Corneal thickness: 450 µm · camera: Topcon TRC-NW400 · intraocular pressure (IOP) 12 mmHg · CFP.
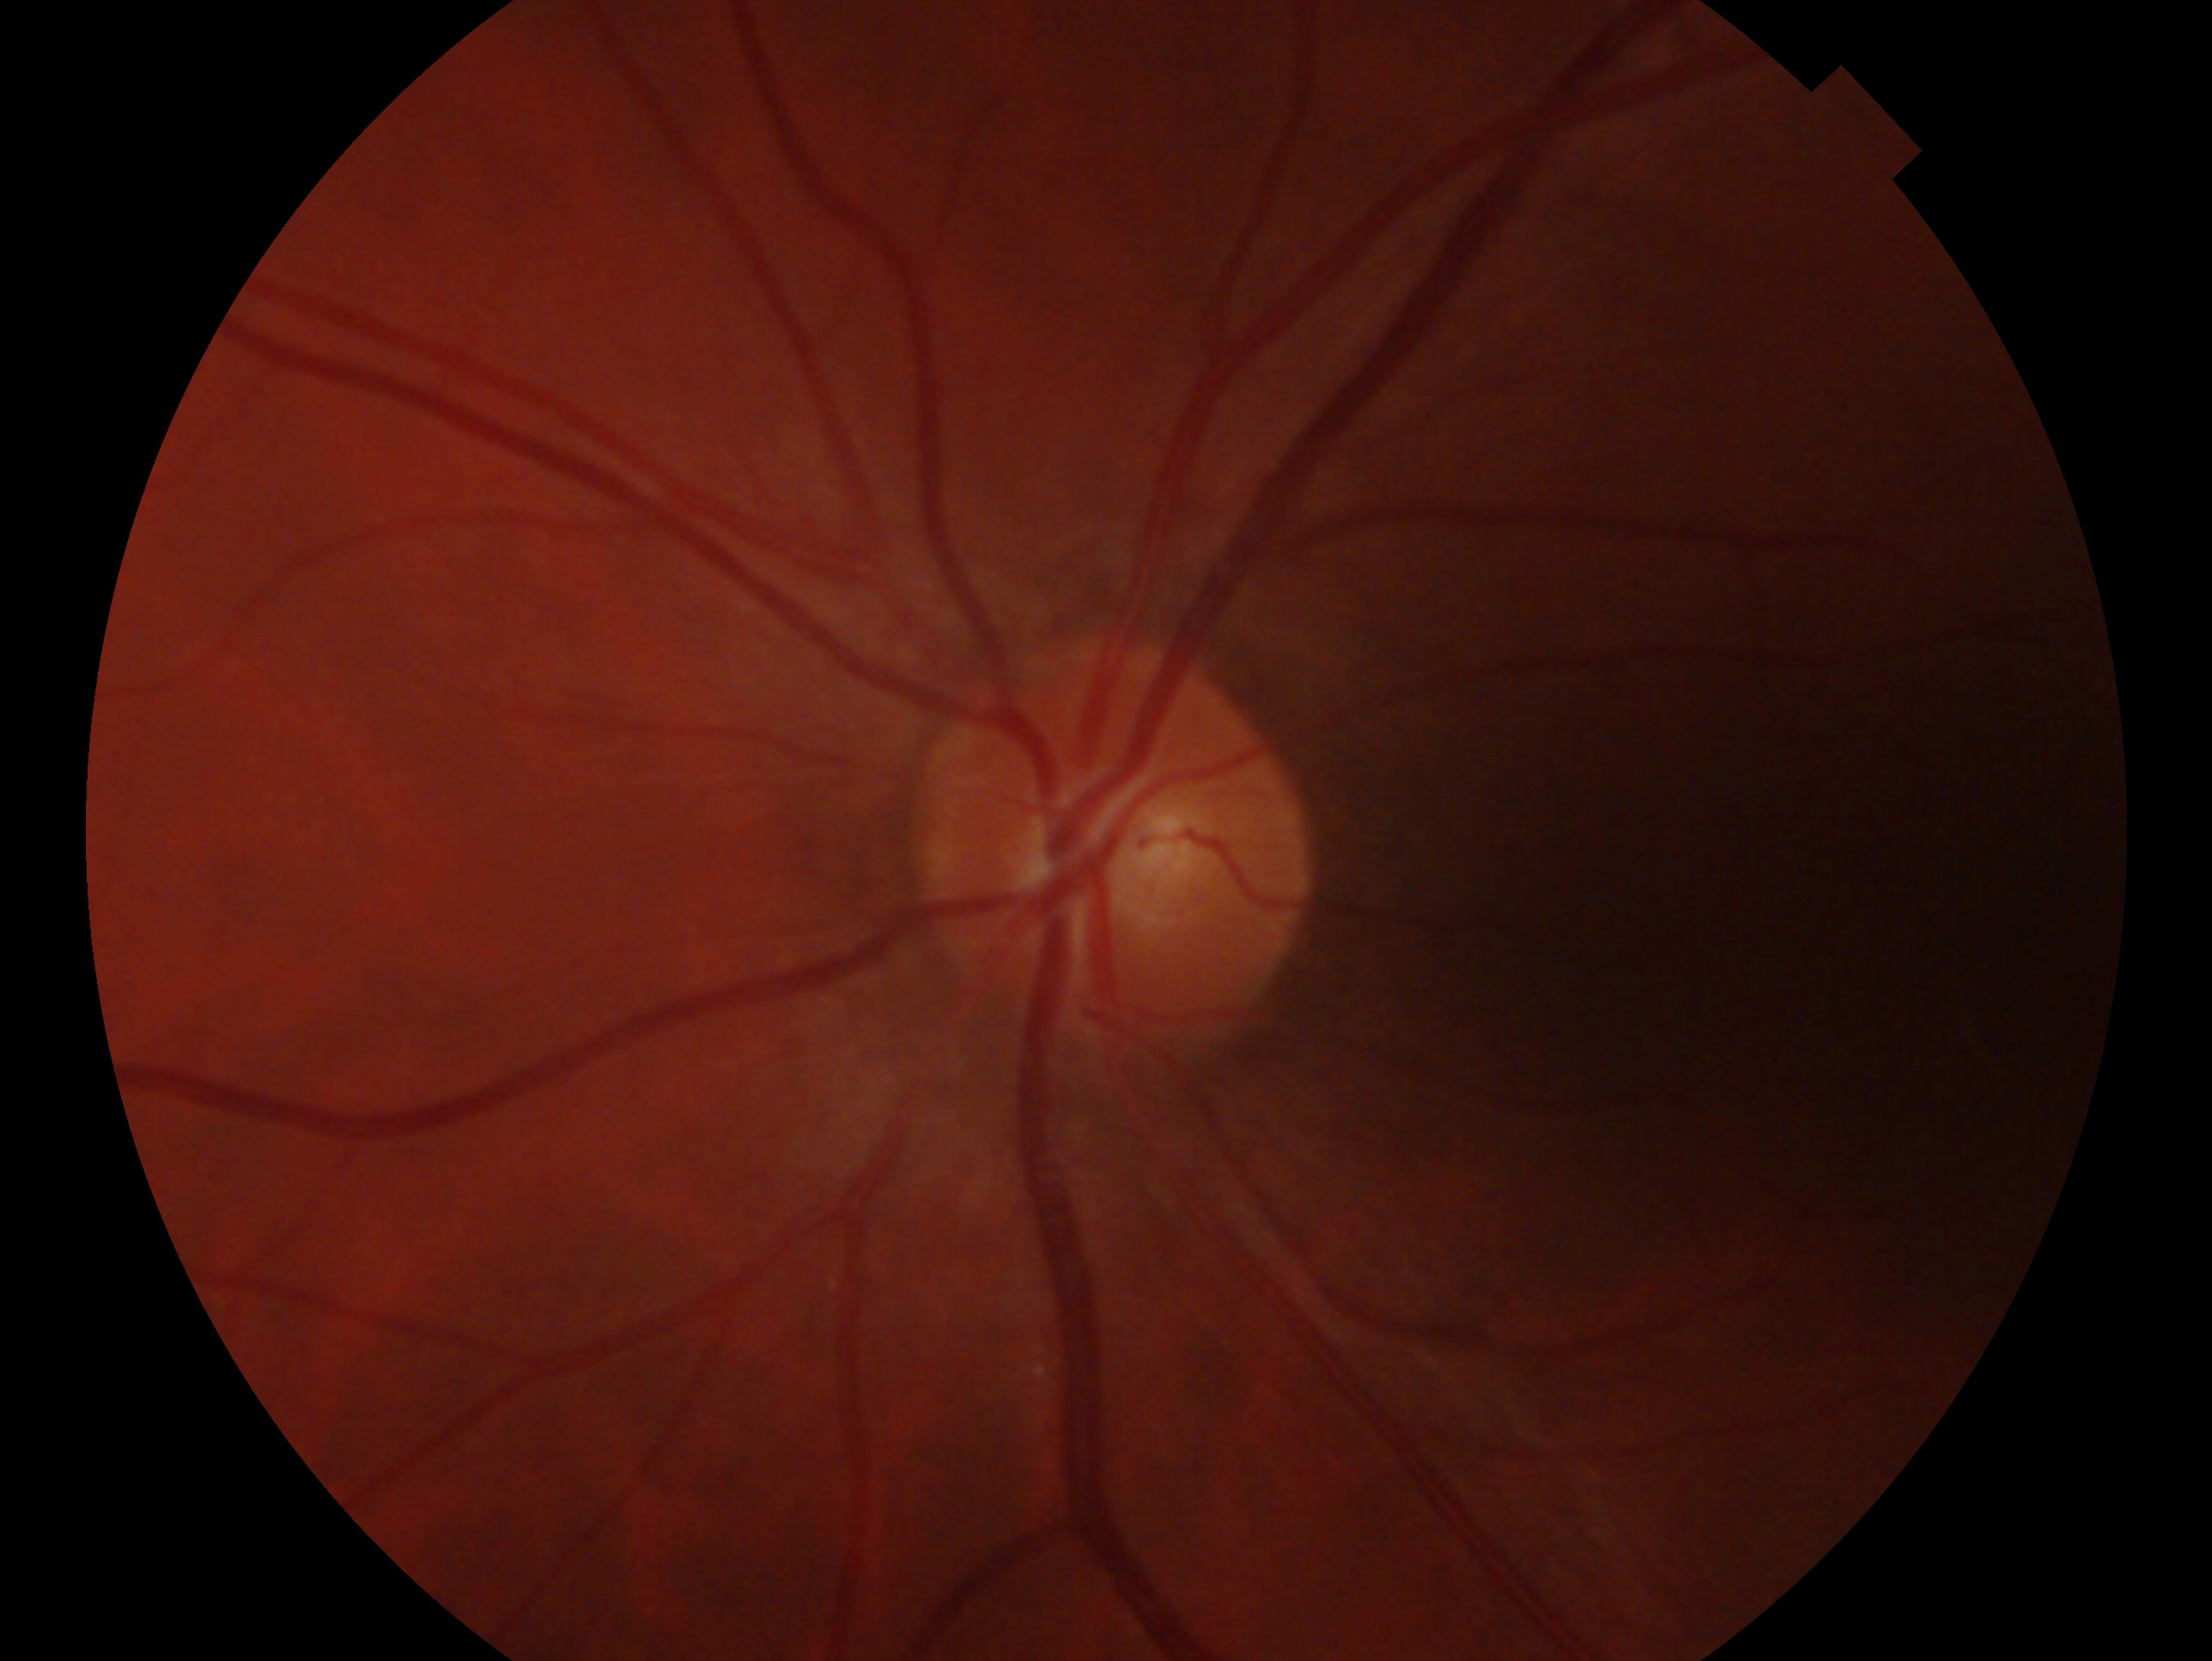 Clinical classification — no signs of glaucoma.
This is the oculus sinister.